NIDEK AFC-230.
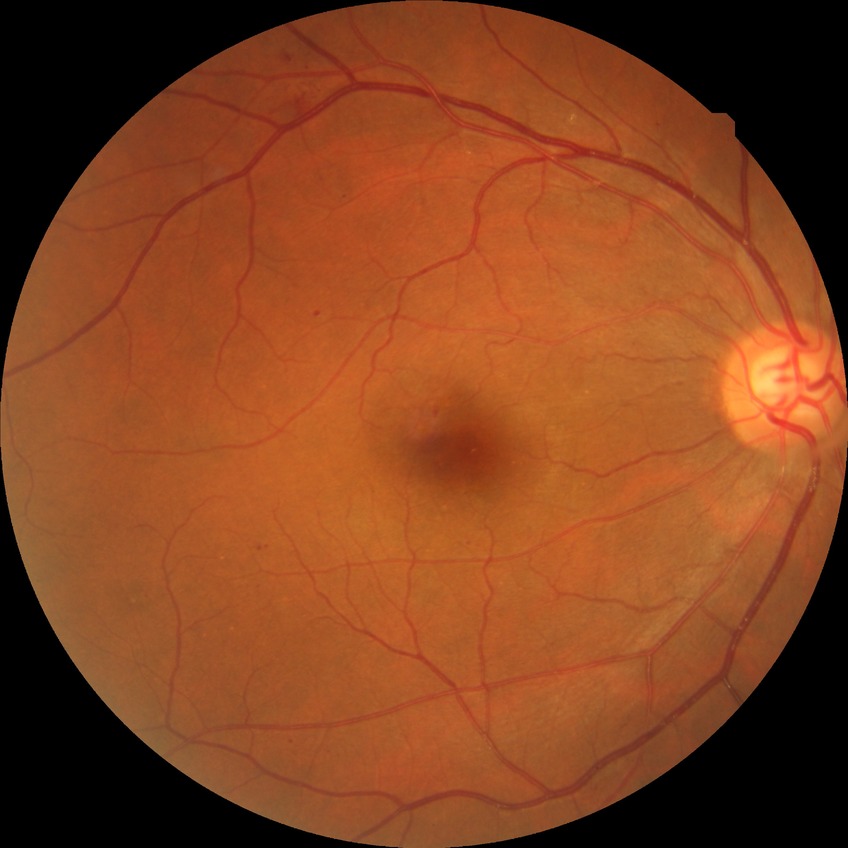
DR class = non-proliferative diabetic retinopathy, retinopathy stage = pre-proliferative diabetic retinopathy.